Infant wide-field fundus photograph; 640x480px.
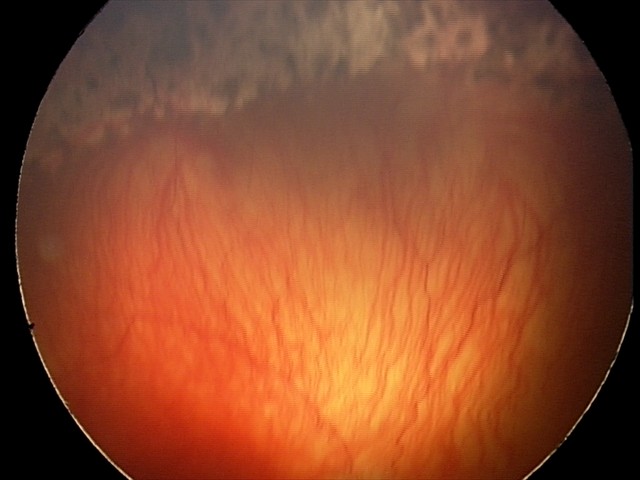

Screening diagnosis = aggressive retinopathy of prematurity, plus form = present.